No pharmacologic dilation. 848 x 848 pixels. Acquired with a NIDEK AFC-230. 45 degree fundus photograph — 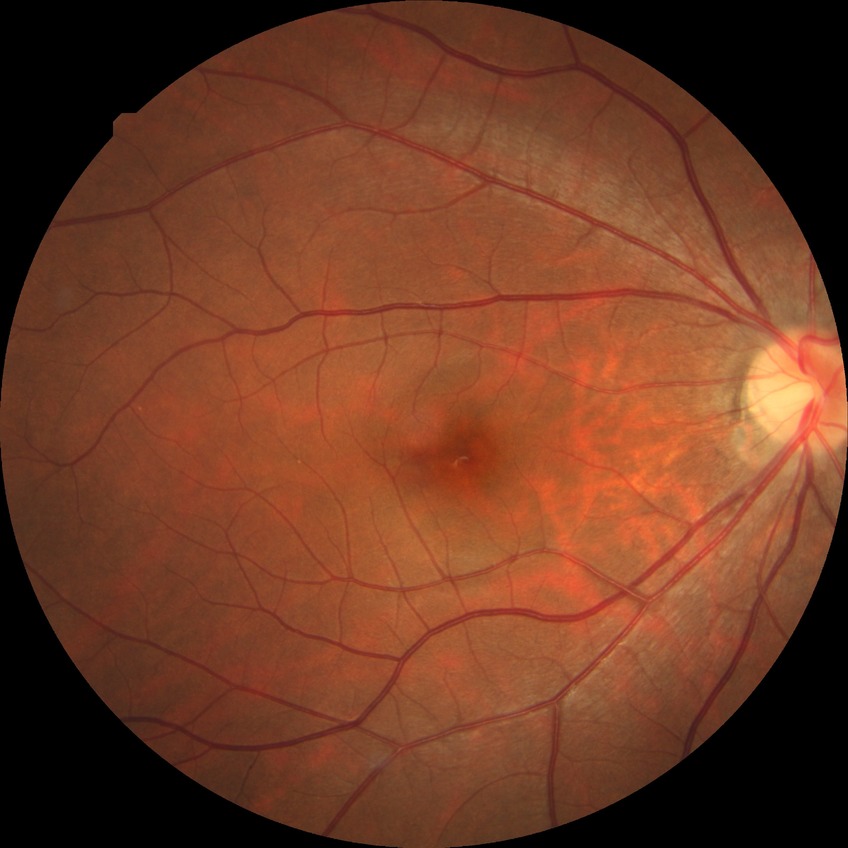 retinopathy grade: no diabetic retinopathy